Wide-field contact fundus photograph of an infant:
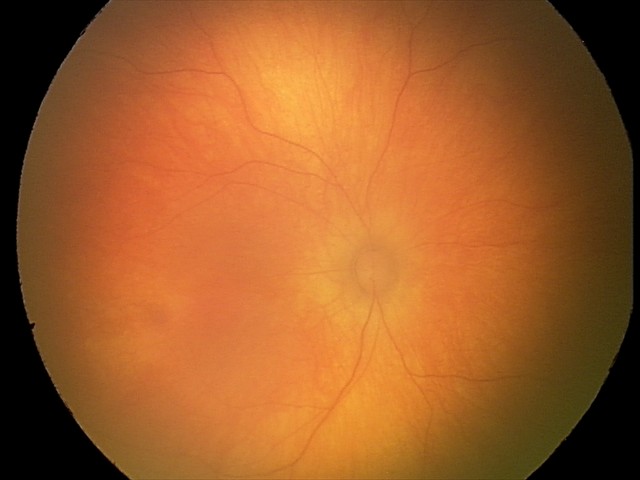

Impression: physiological retinal finding.